Wide-field fundus photograph from neonatal ROP screening.
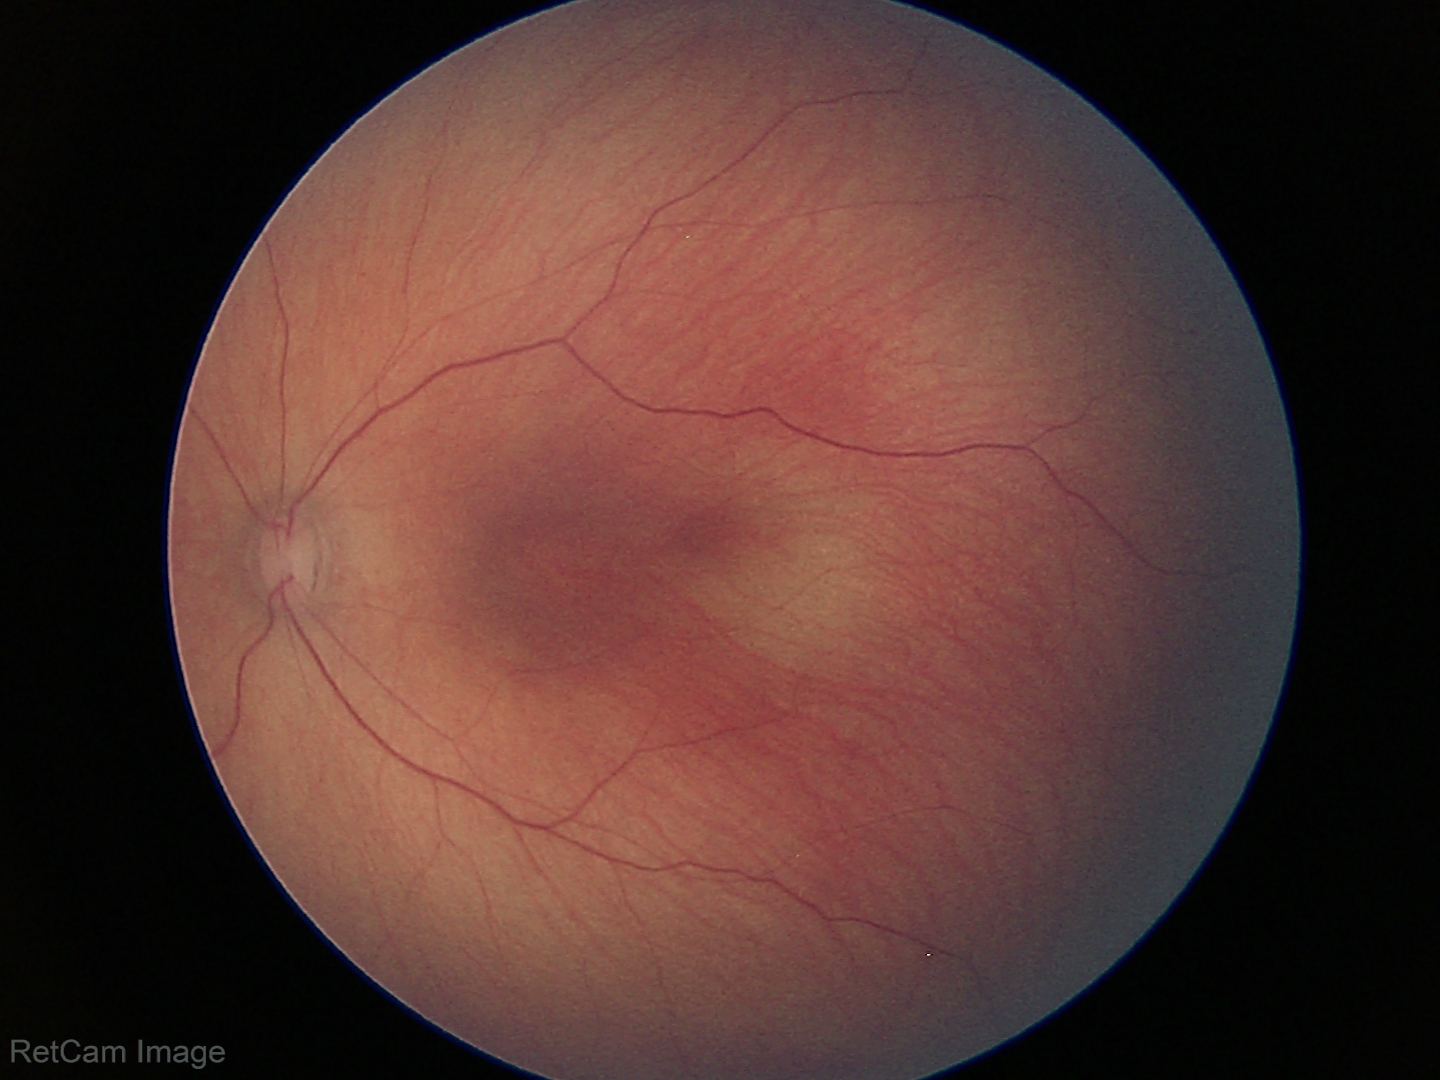 Screening: normal fundus examination.